45-degree field of view · image size 2352x1568 · color fundus image:
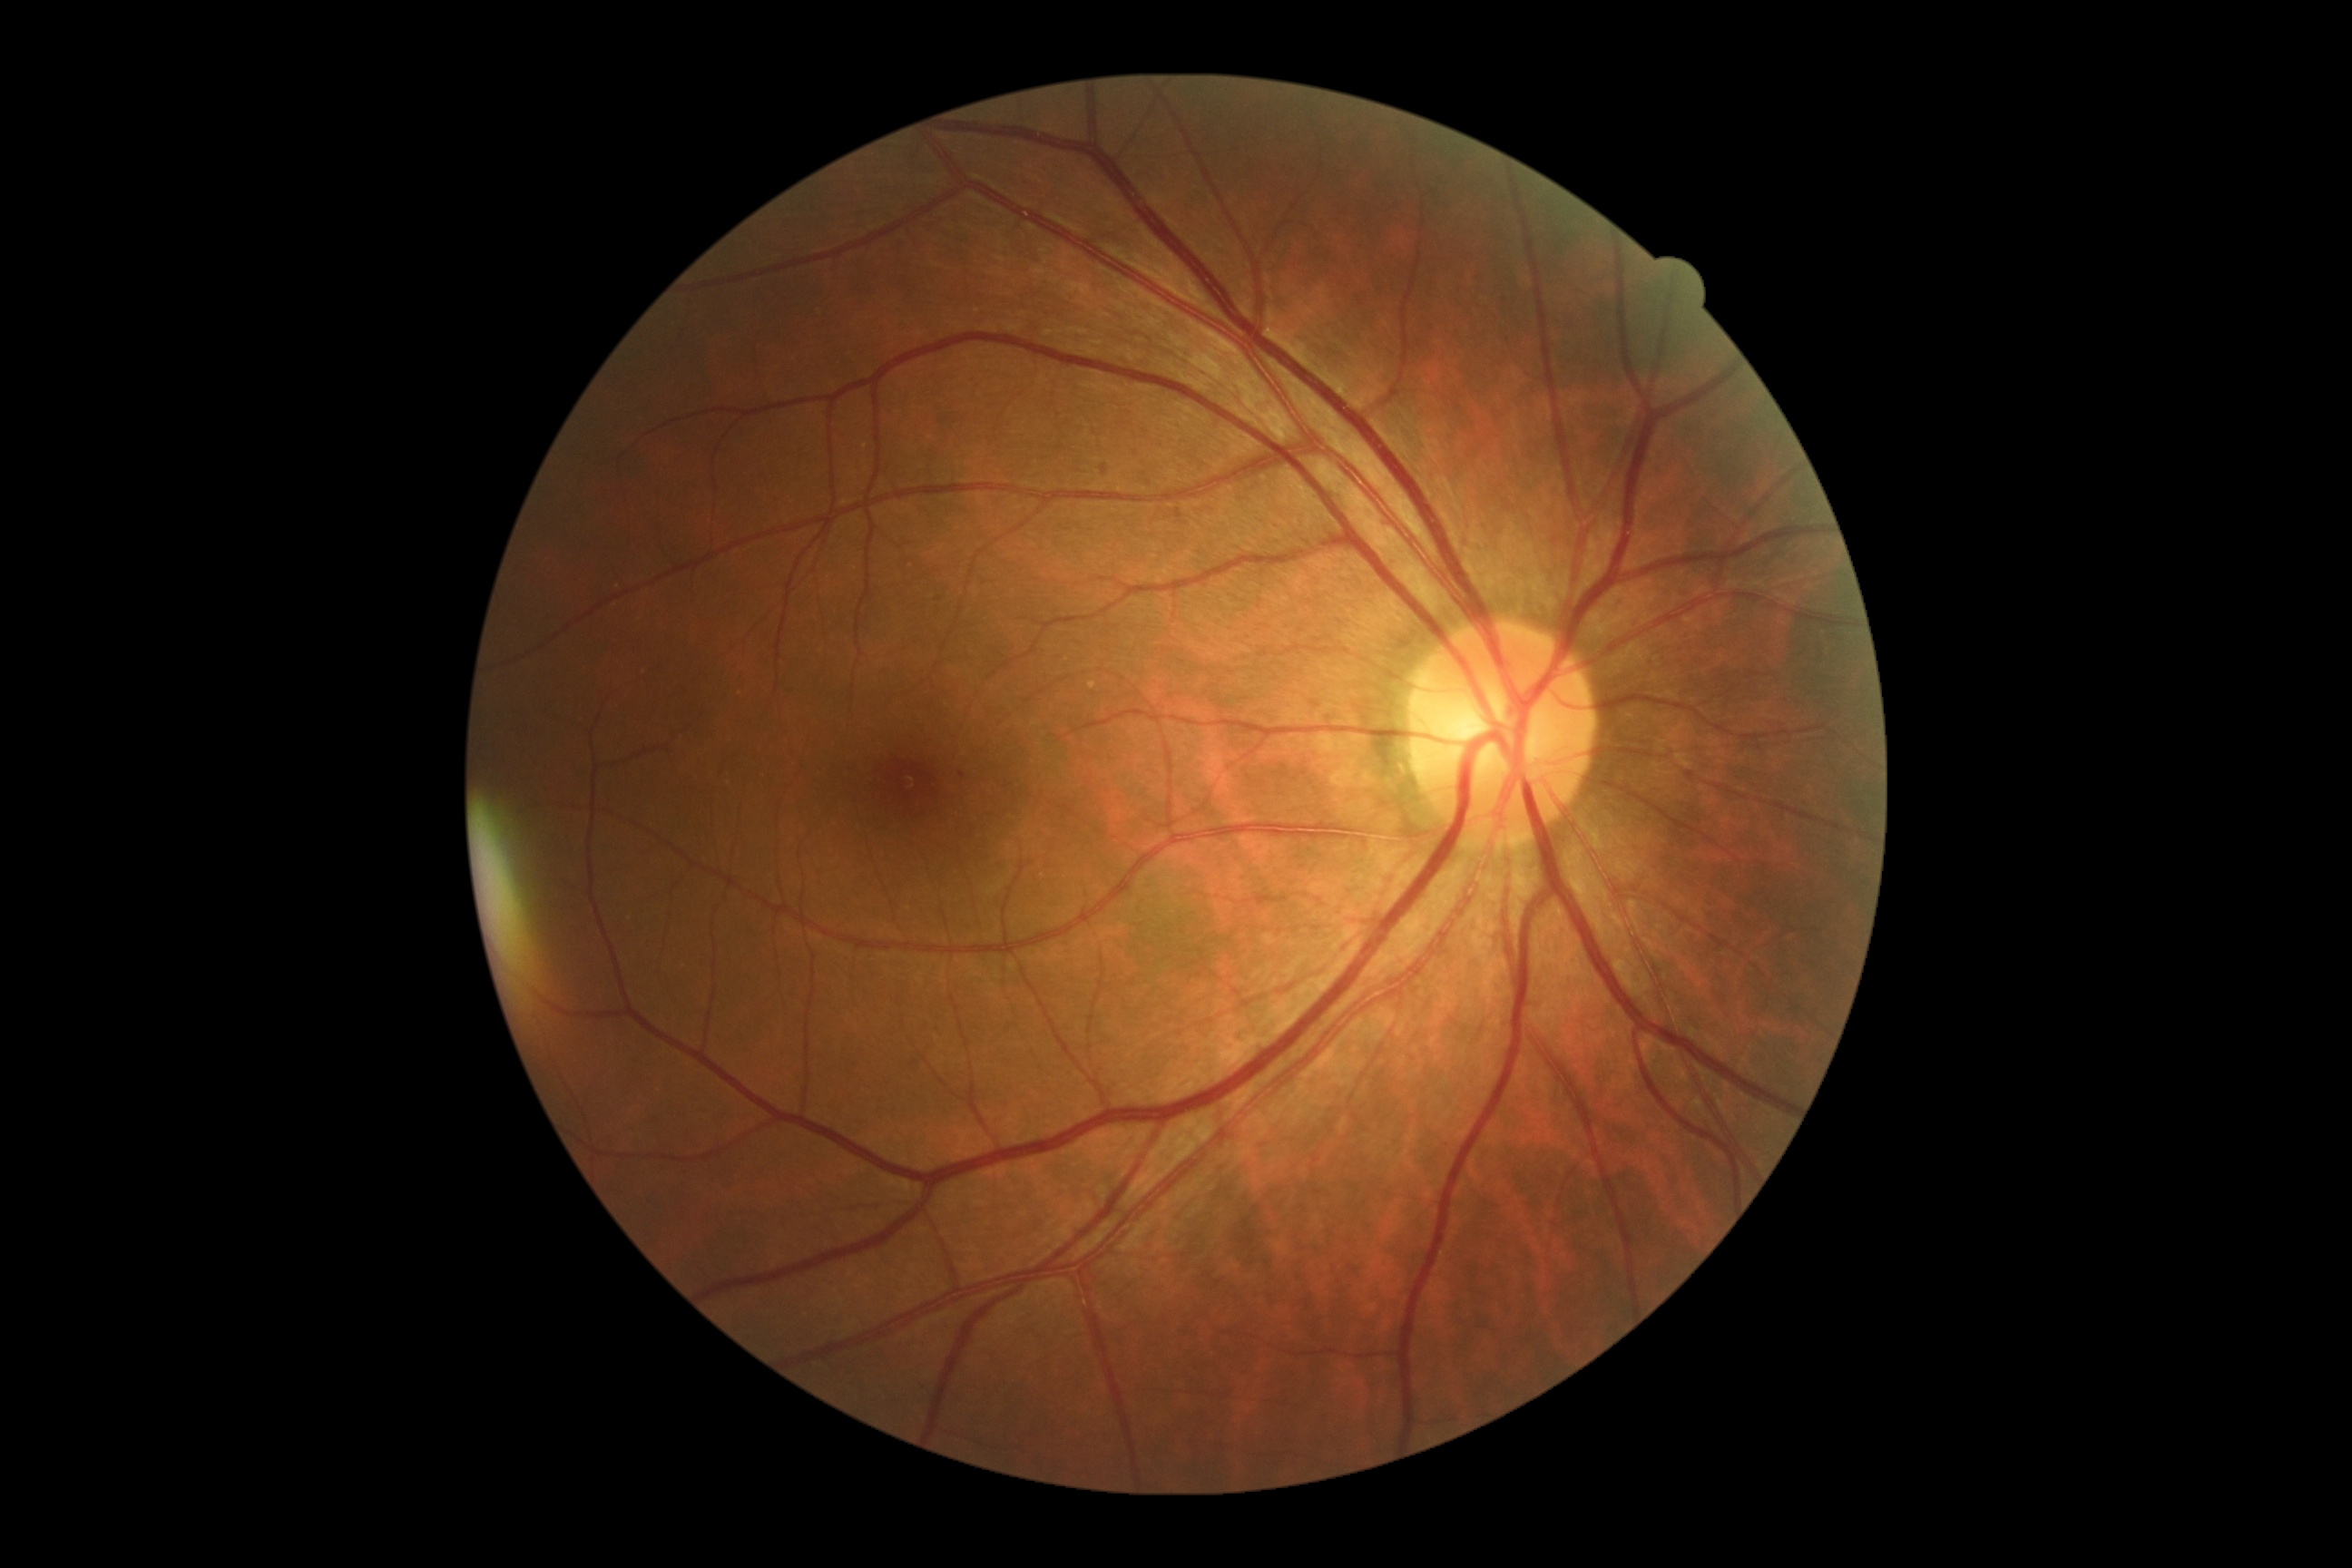

Diabetic retinopathy (DR) is 1/4 — presence of microaneurysms only.